Fundus photo, 45-degree field of view — 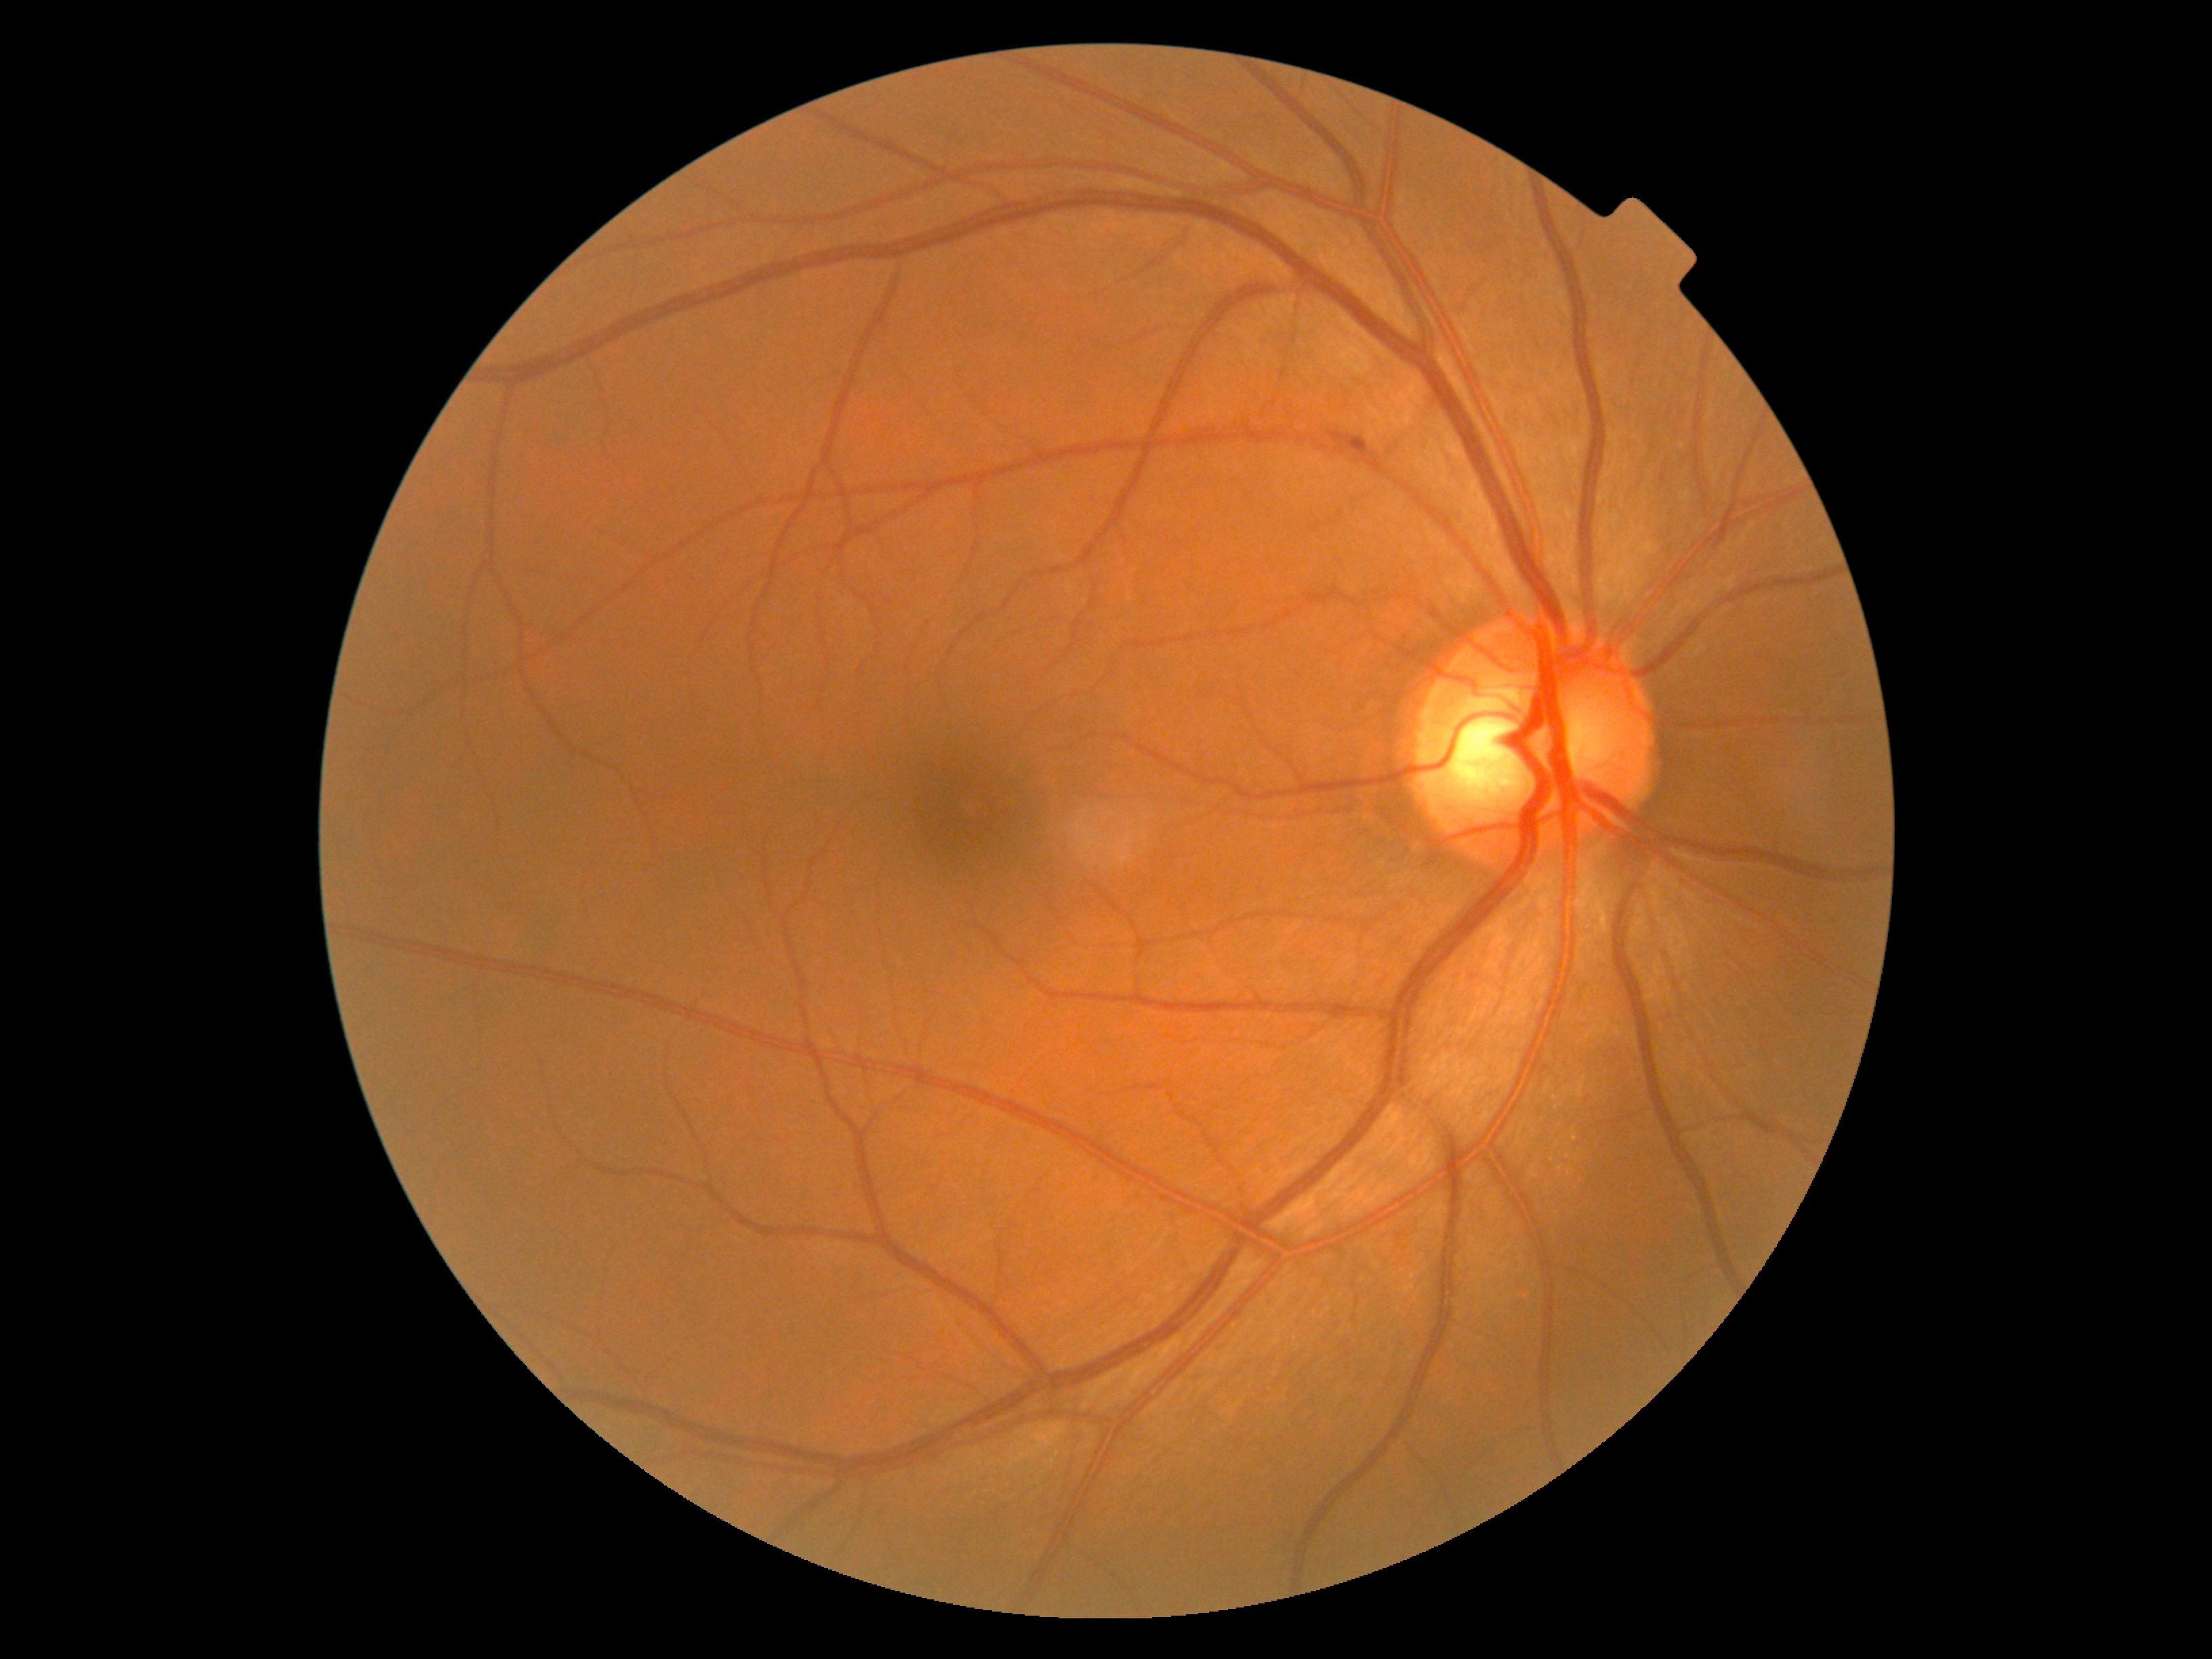
DR severity = grade 1 (mild NPDR) — presence of microaneurysms only.